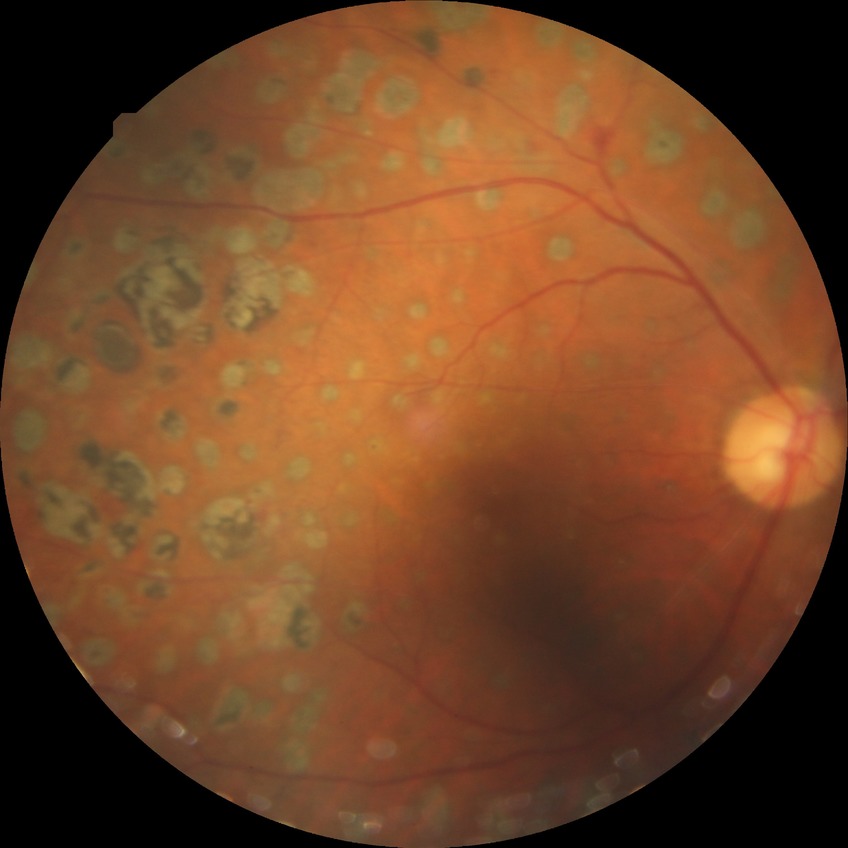

modified Davis grading: proliferative diabetic retinopathy.